CFP:
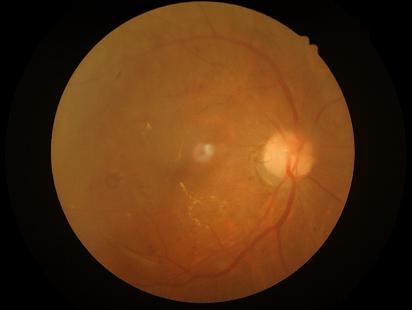 {
  "clarity": "reduced",
  "overall_quality": "low",
  "contrast": "adequate"
}